Phoenix ICON wide-field infant fundus image — 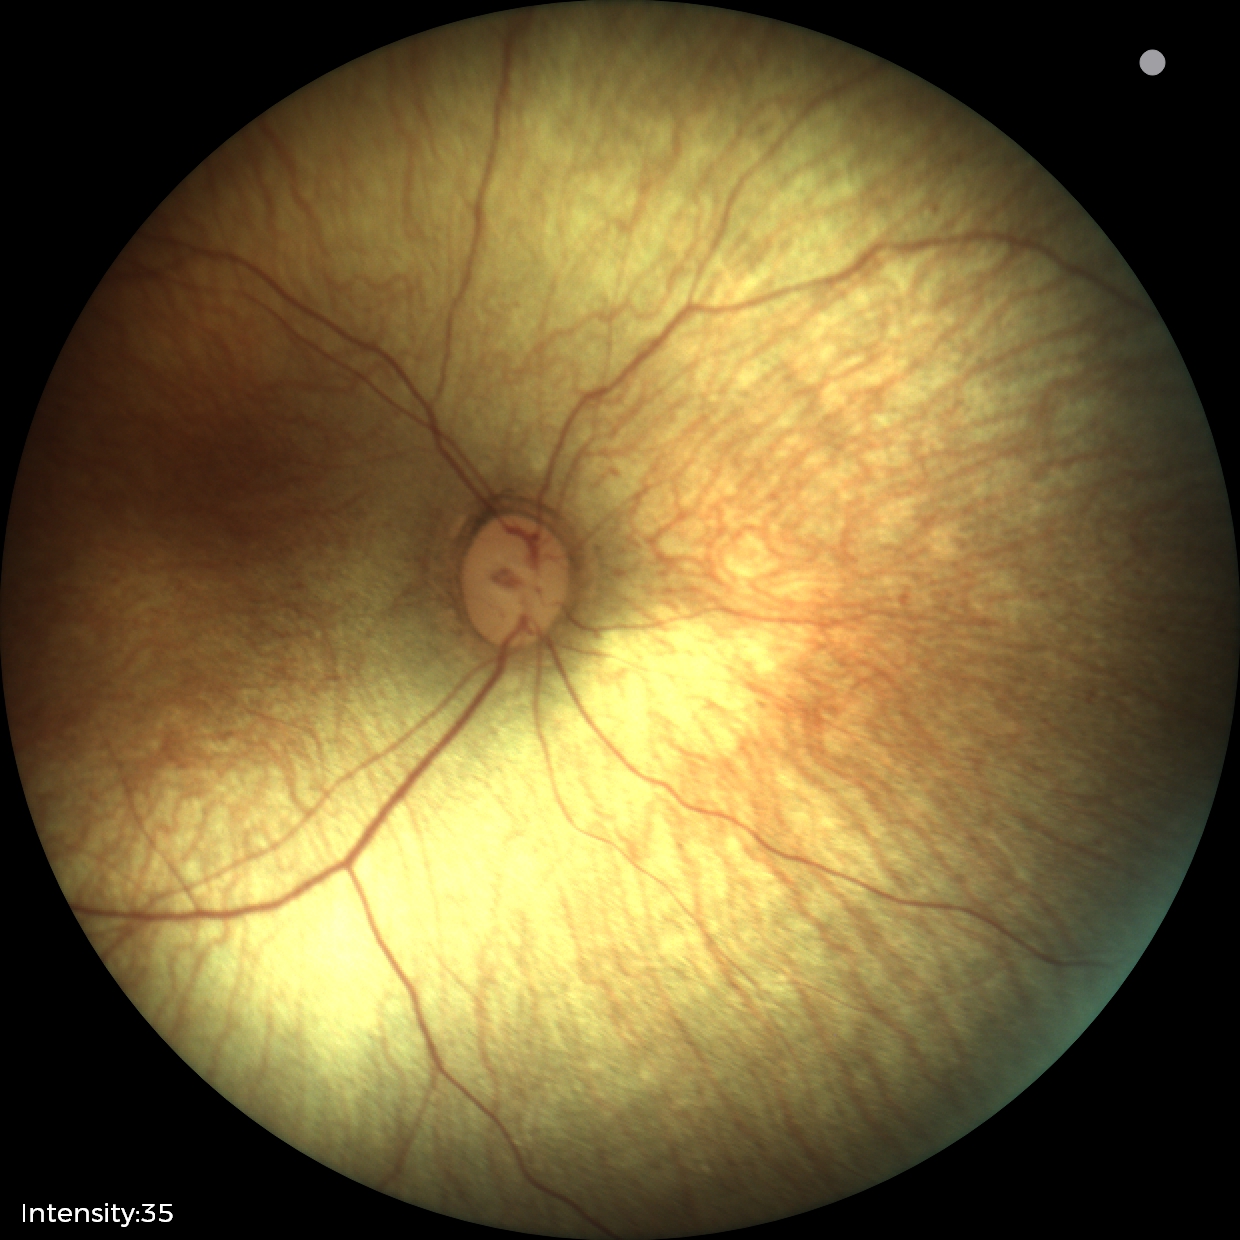

Screening examination diagnosed as physiological.